Camera: NIDEK AFC-230; 848 by 848 pixels
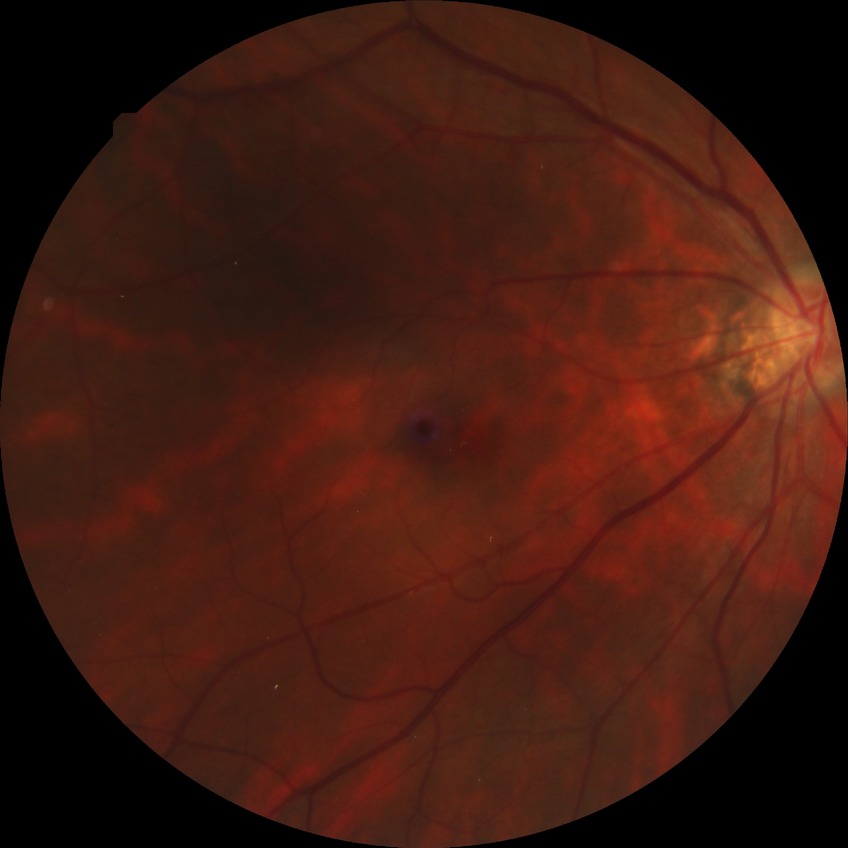
Diabetic retinopathy (DR): NDR (no diabetic retinopathy).